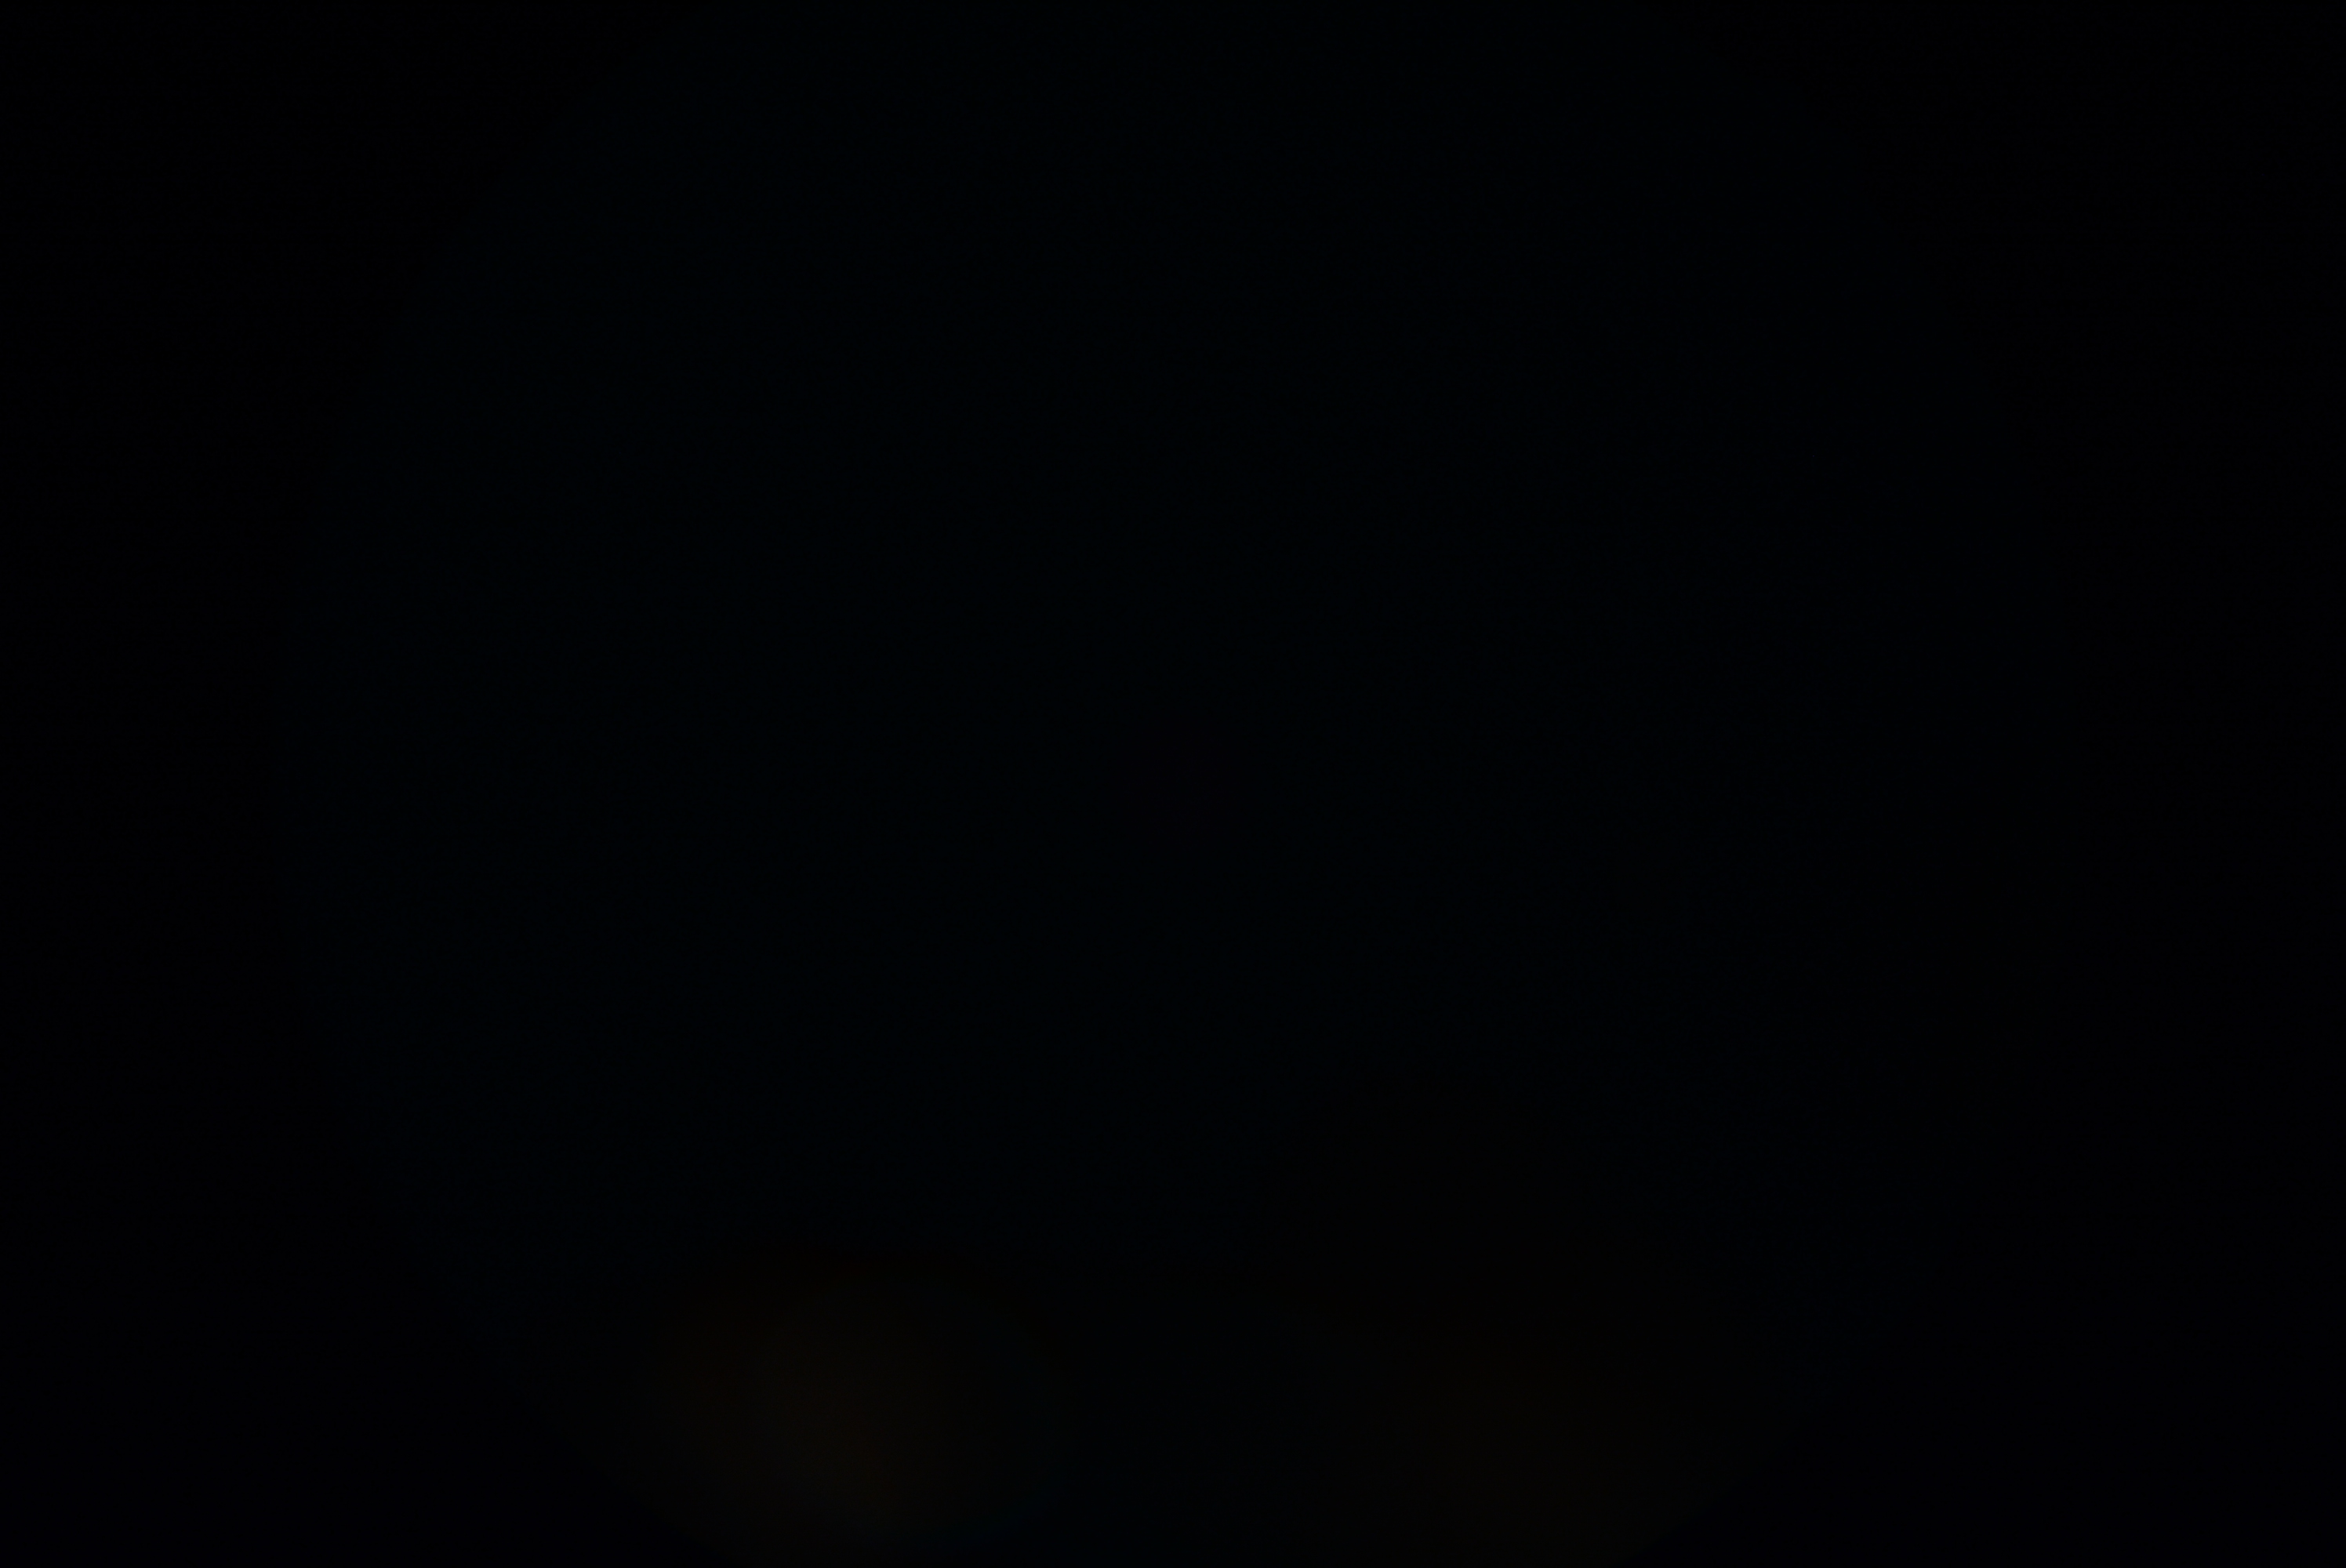

image quality: below grading threshold, DR severity: ungradable.